Acquired with a NIDEK AFC-230. 45 degree fundus photograph — 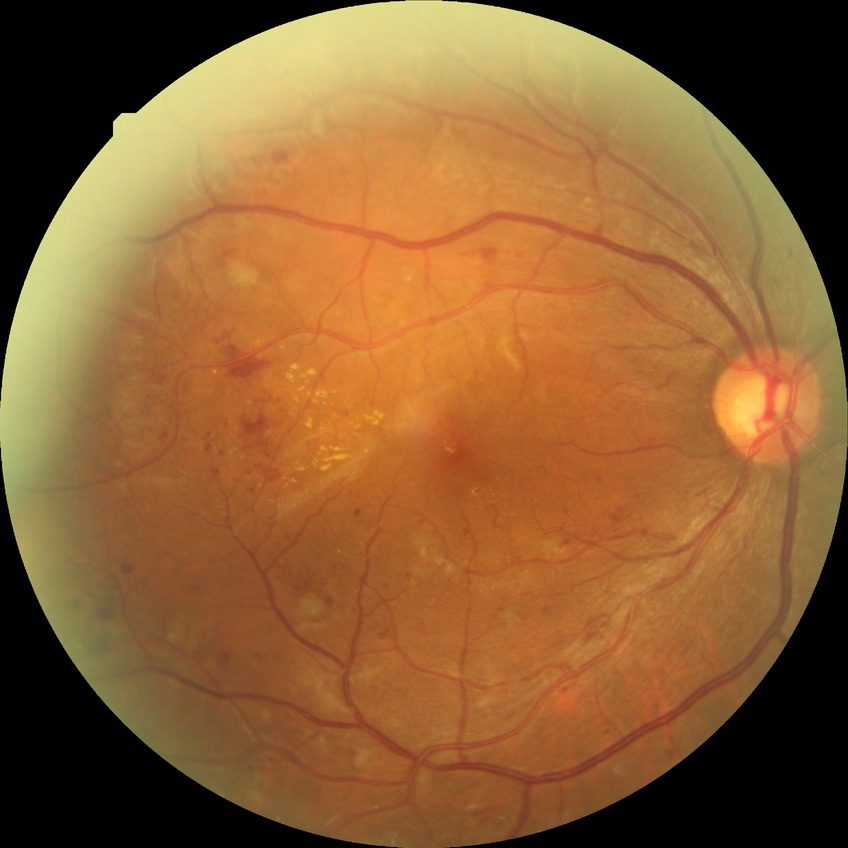
DR class: non-proliferative diabetic retinopathy
diabetic retinopathy (DR): pre-proliferative diabetic retinopathy (PPDR)